Captured on a Topcon TRC retinal camera · optic disc photograph:
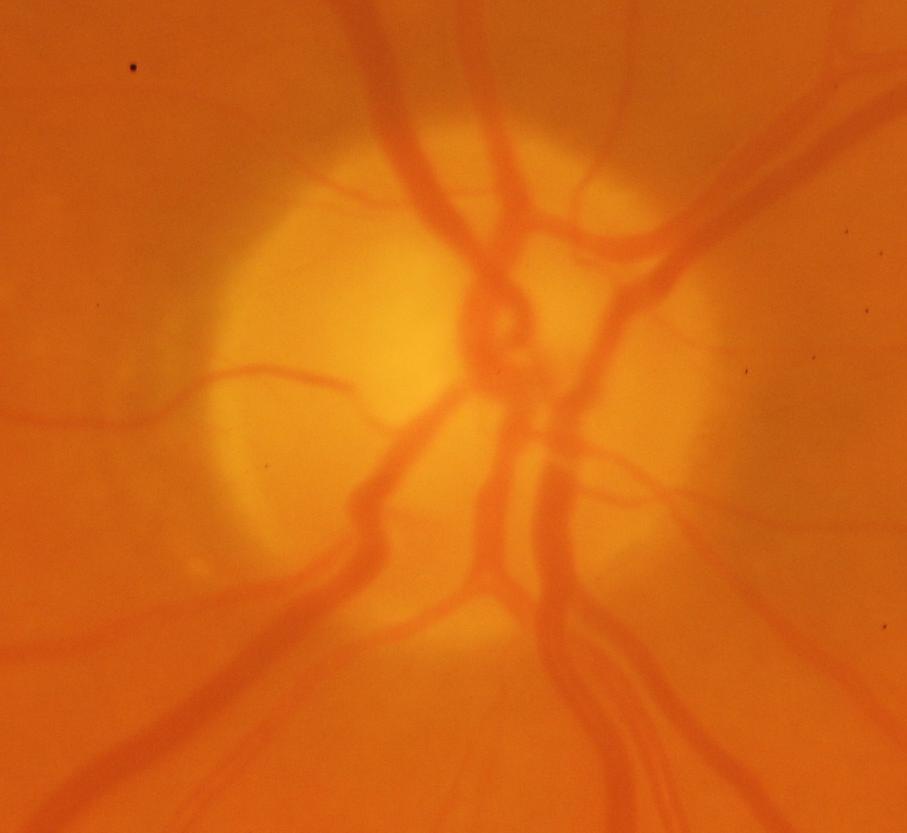

Glaucoma is present. Optic disc appearance consistent with glaucomatous changes.